2352 x 1568 pixels — 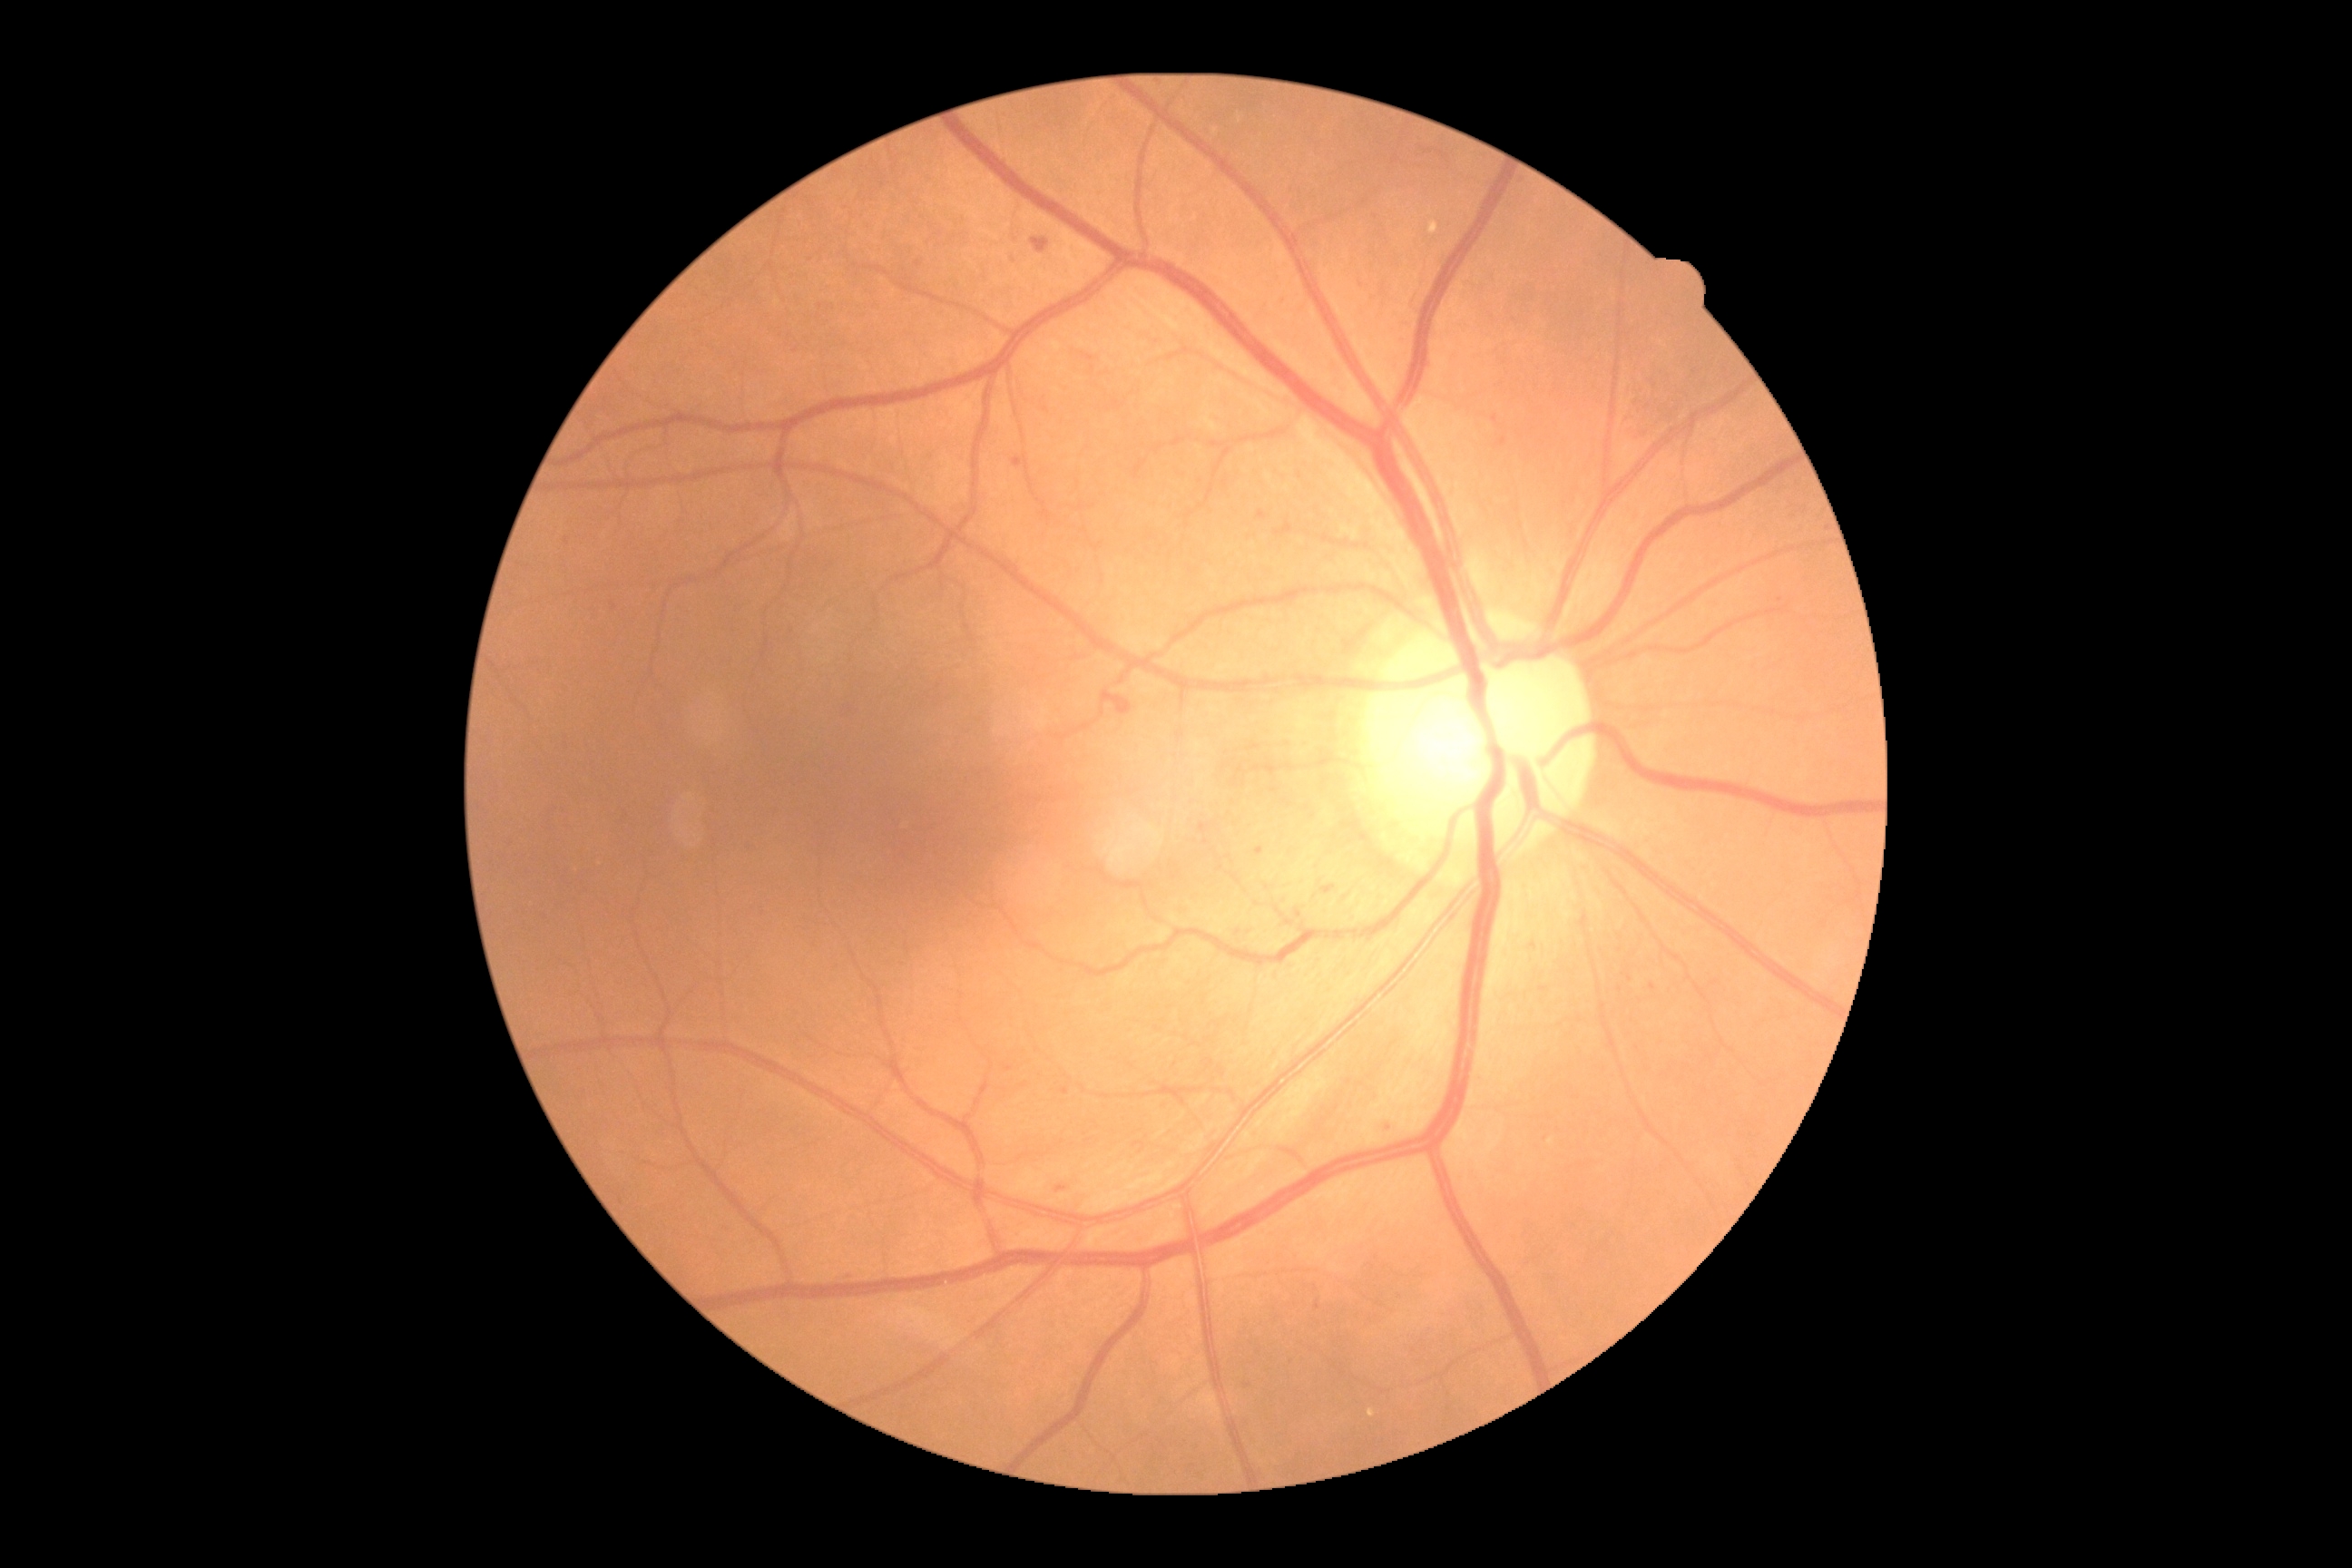 Diabetic retinopathy severity is 2.